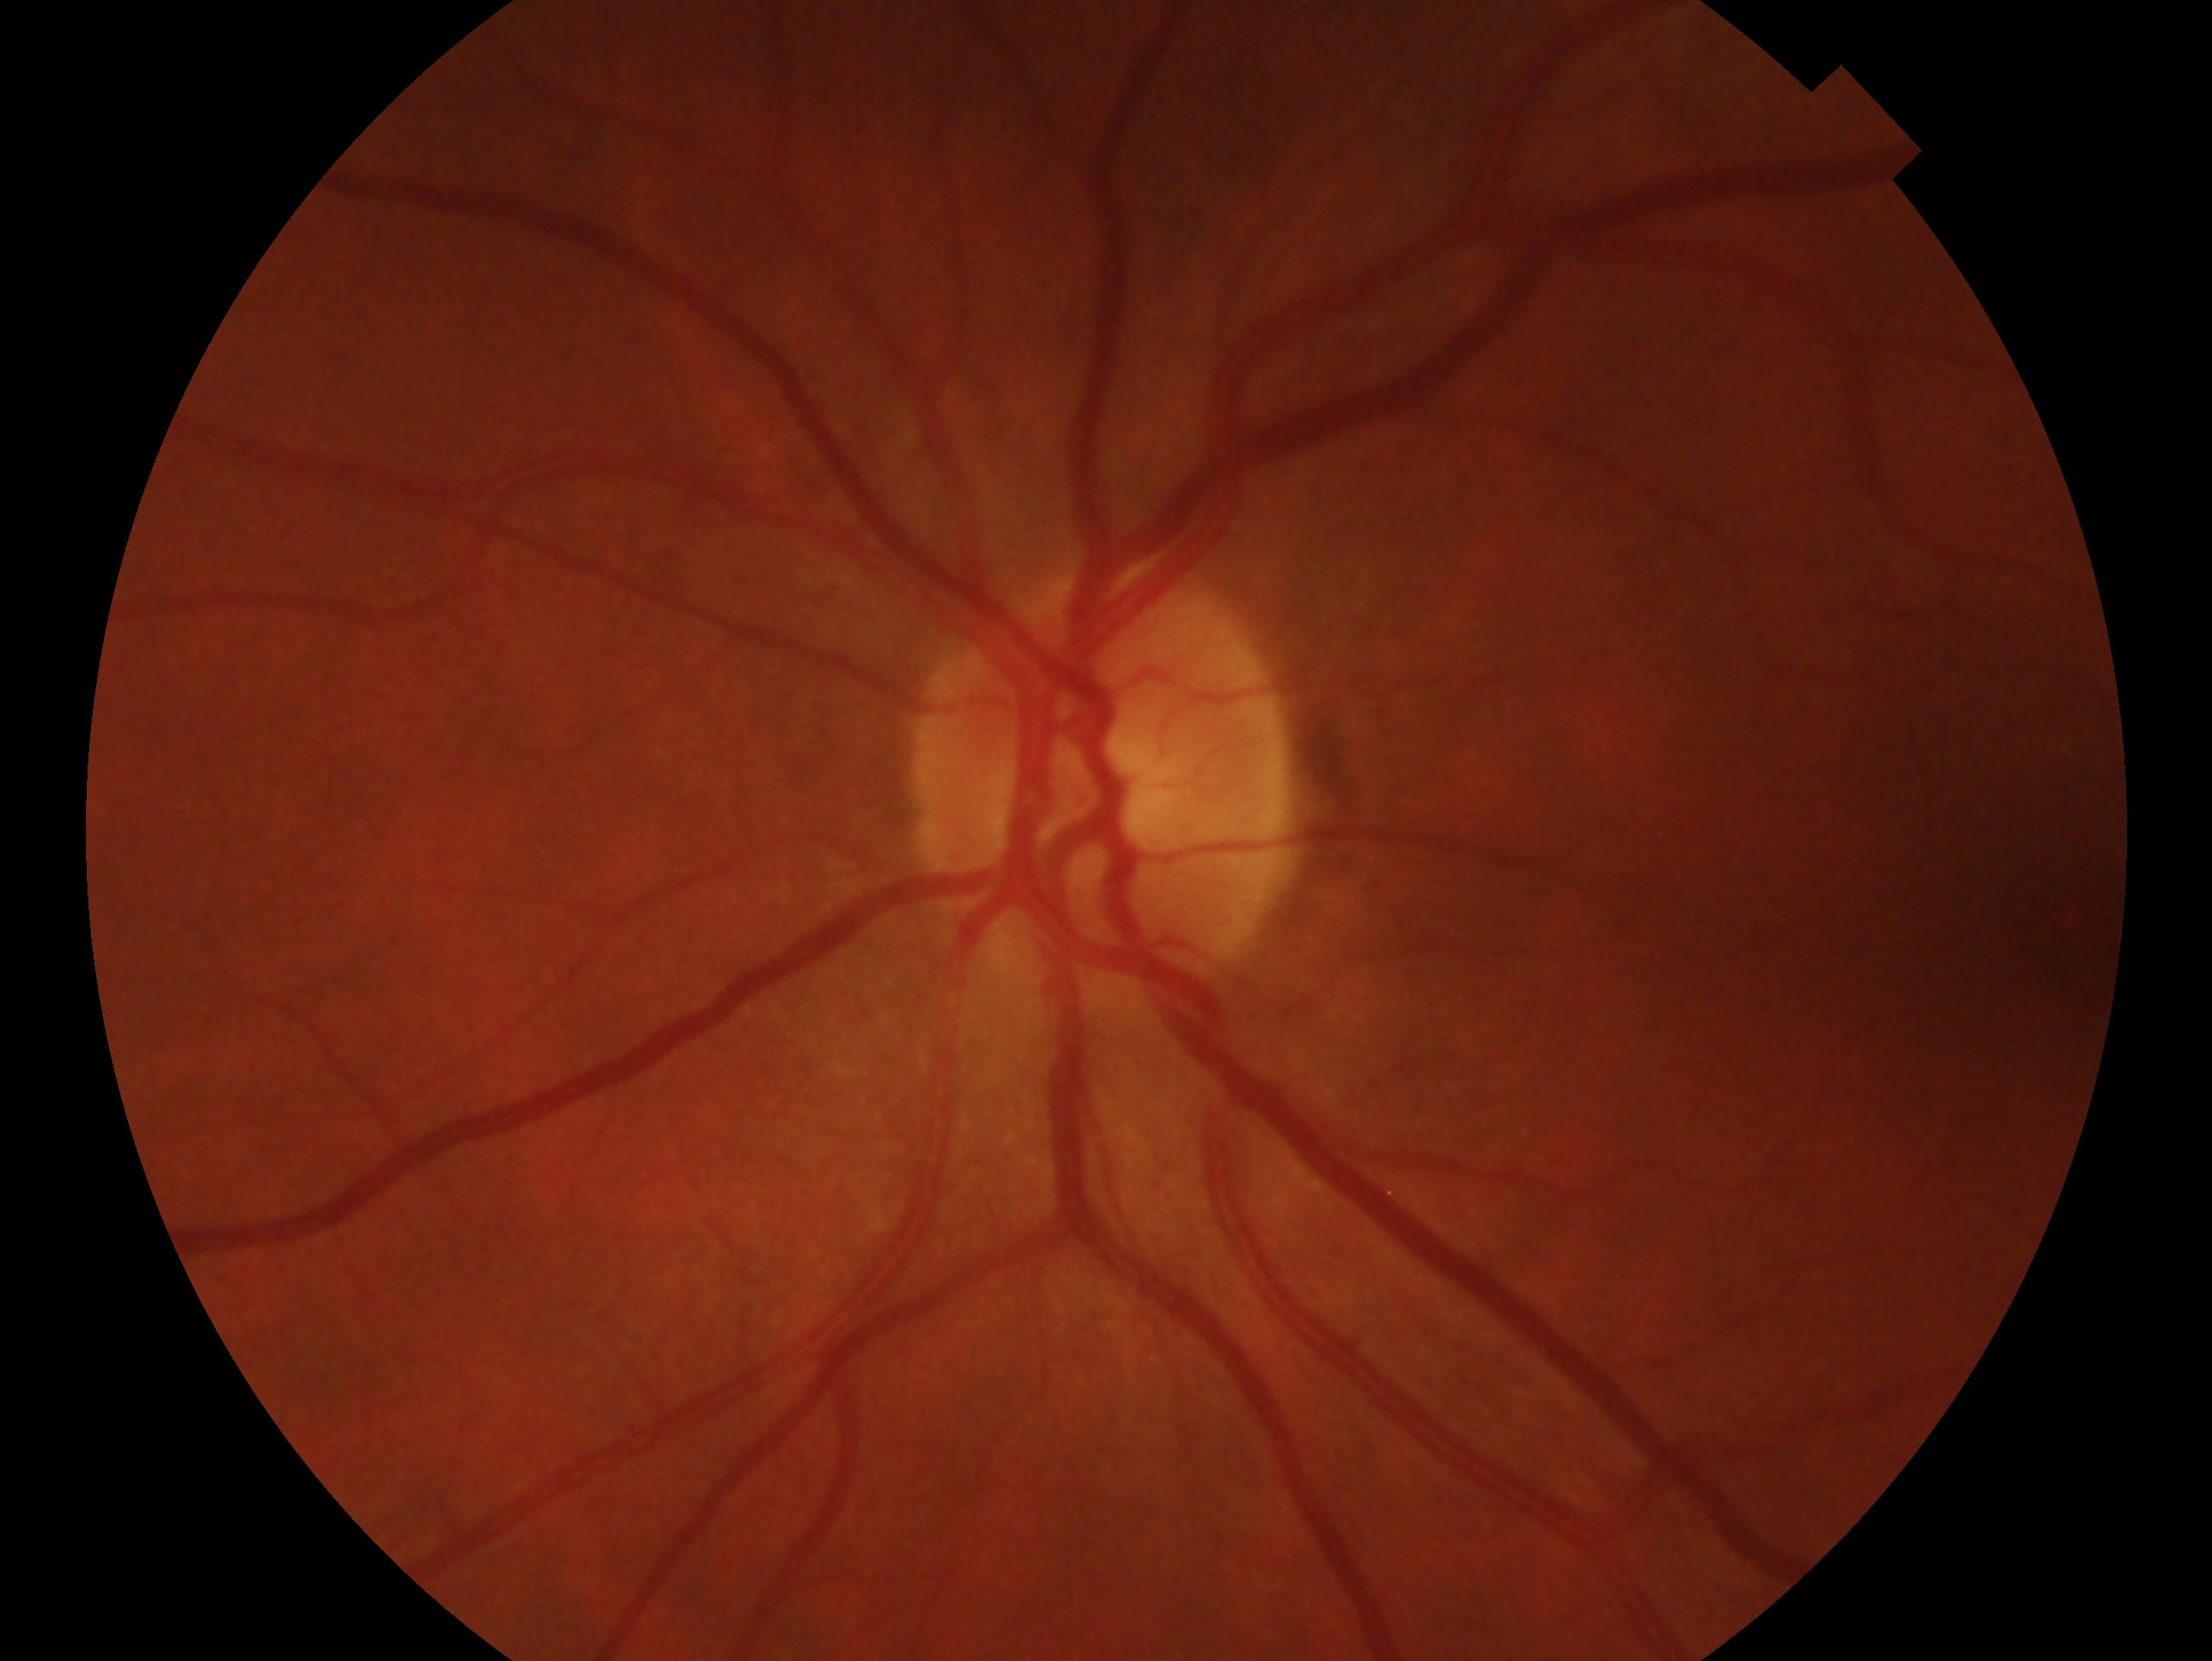
The image shows the left eye.
Glaucoma assessment: negative for glaucoma — no clinical evidence of glaucoma in this eye.